Wide-field retinal mosaic image — 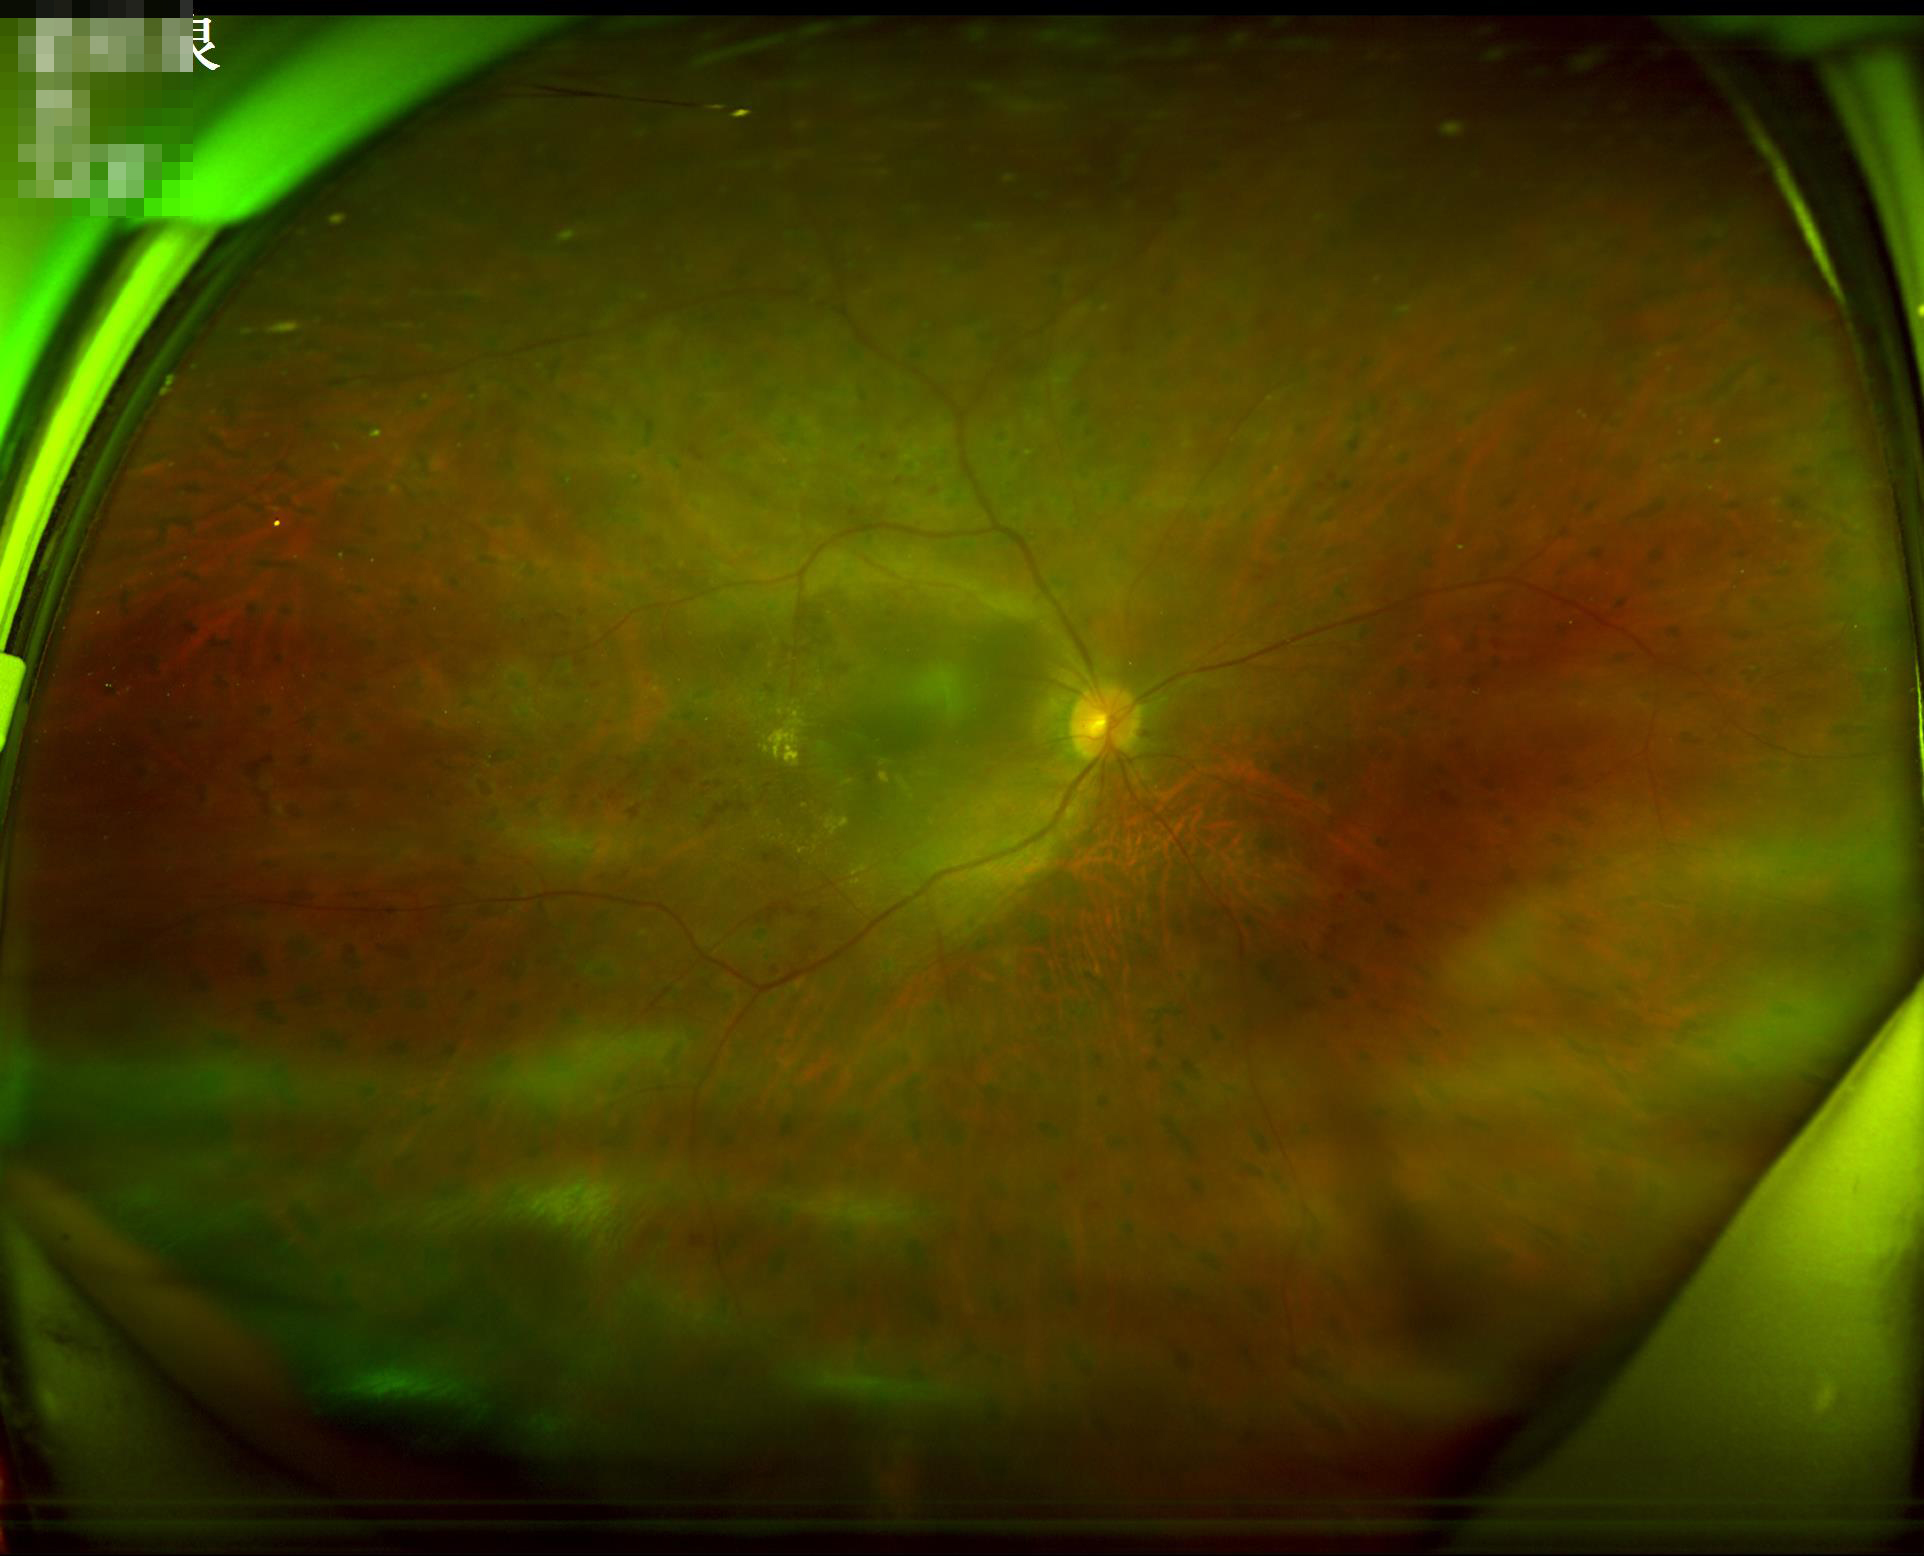 Image quality assessment: clarity: clear | overall: poor | illumination: poor.